Pediatric wide-field fundus photograph
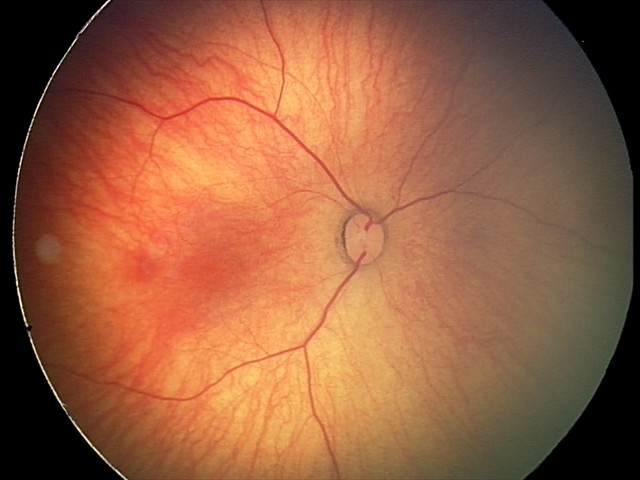
Finding: retinal hemorrhages.